DR severity per modified Davis staging, color fundus photograph:
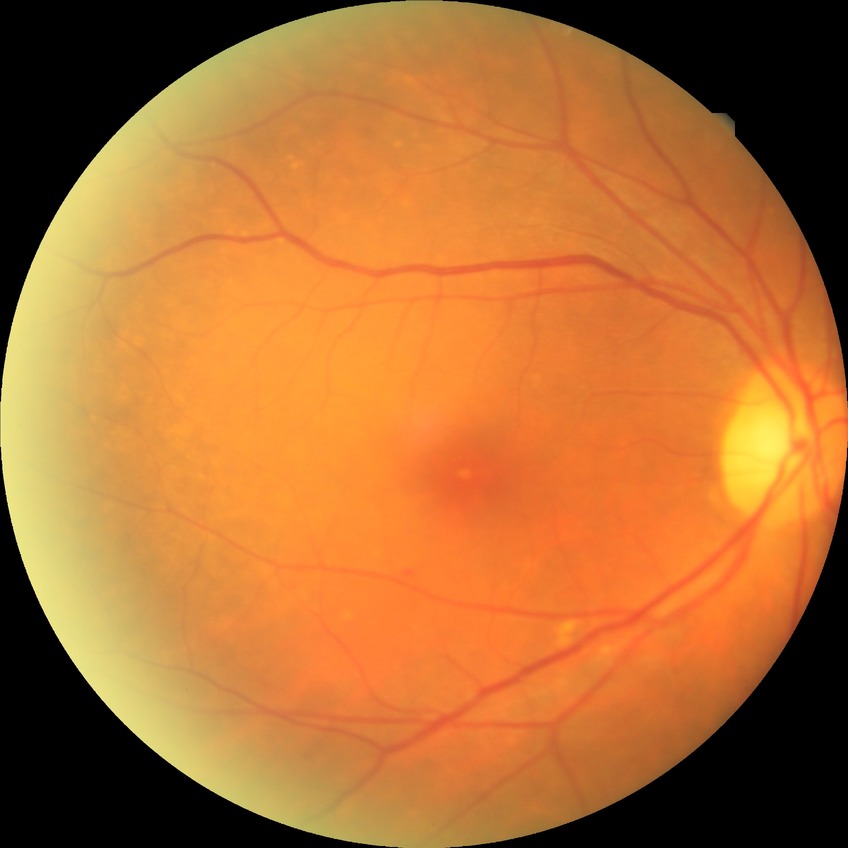

DR impression: negative for DR | Davis stage: NDR.